45° field of view: 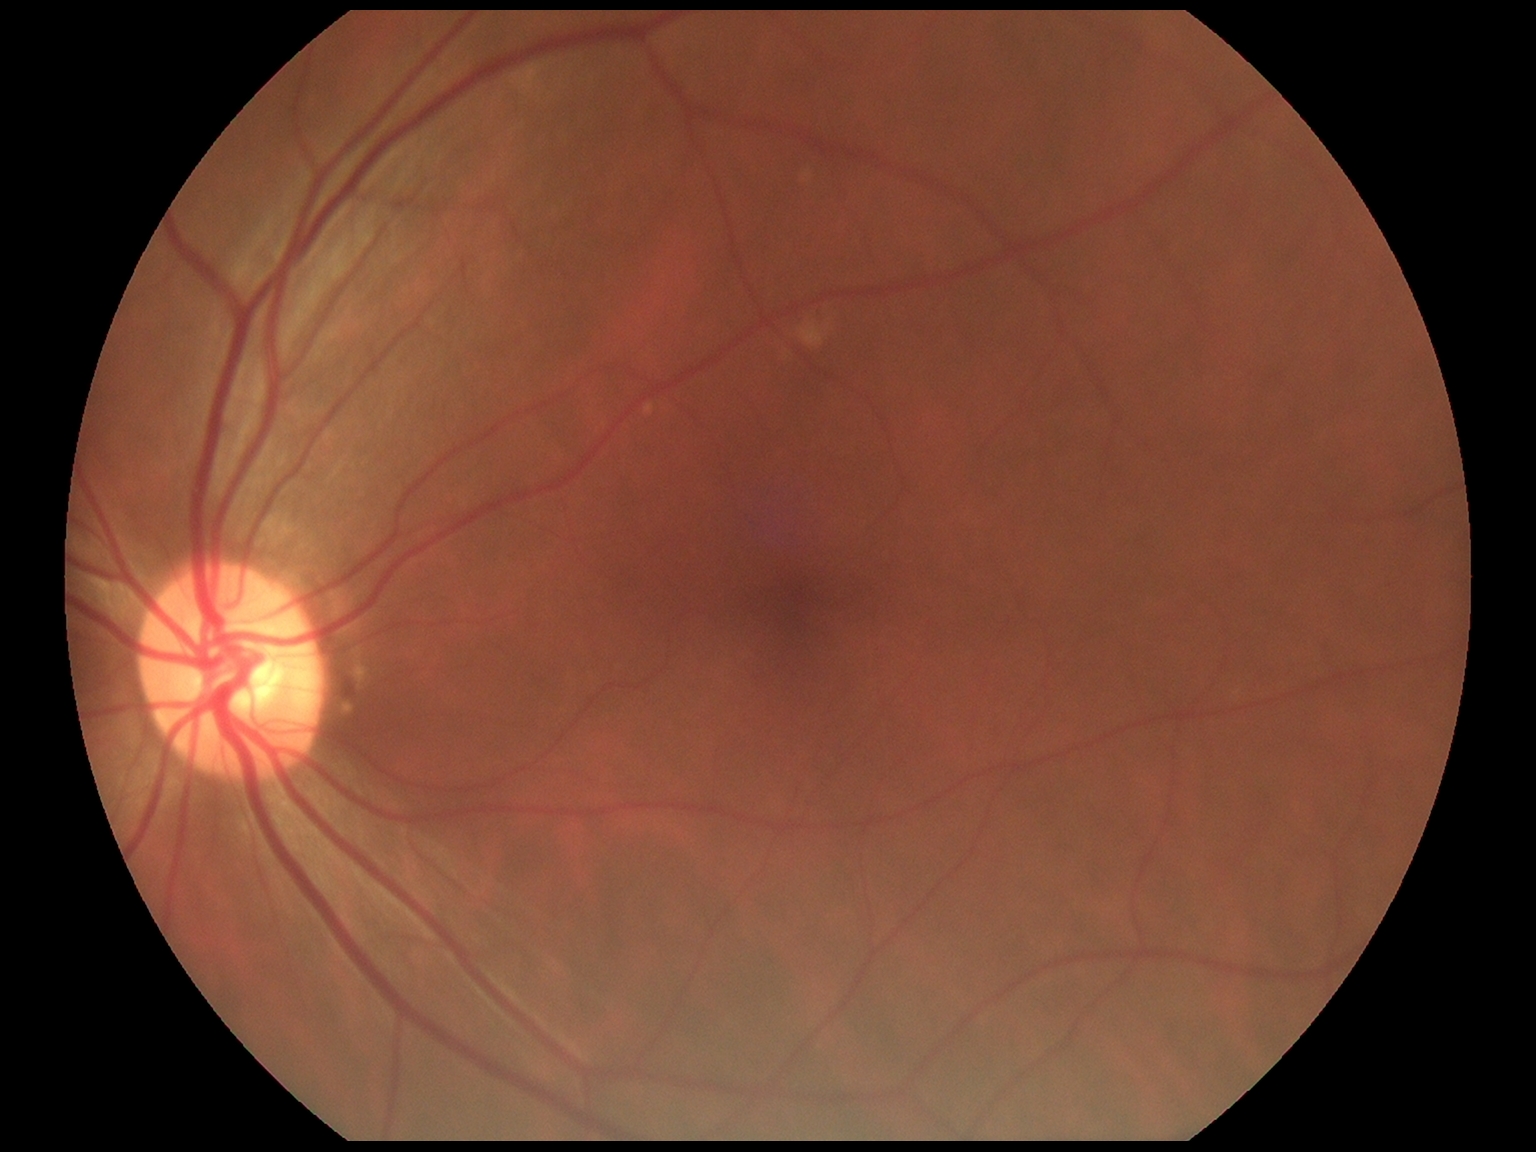
No signs of diabetic retinopathy.
Diabetic retinopathy (DR) is 0/4.